Posterior pole photograph · acquired with a NIDEK AFC-230.
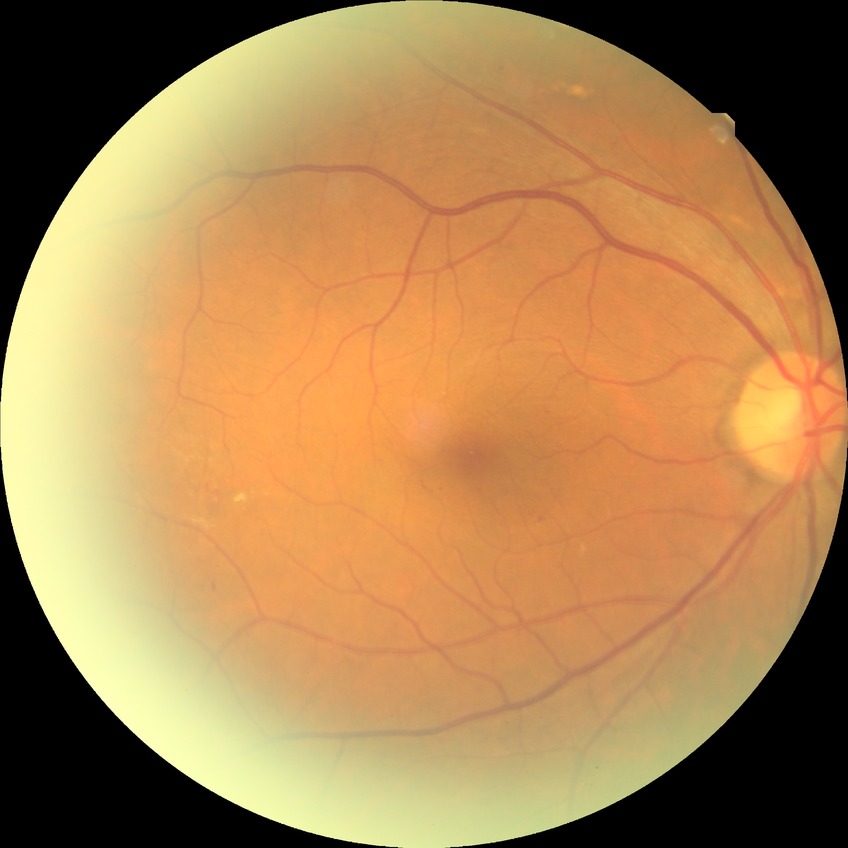 DR stage: SDR.